50° FOV; 2361x1568
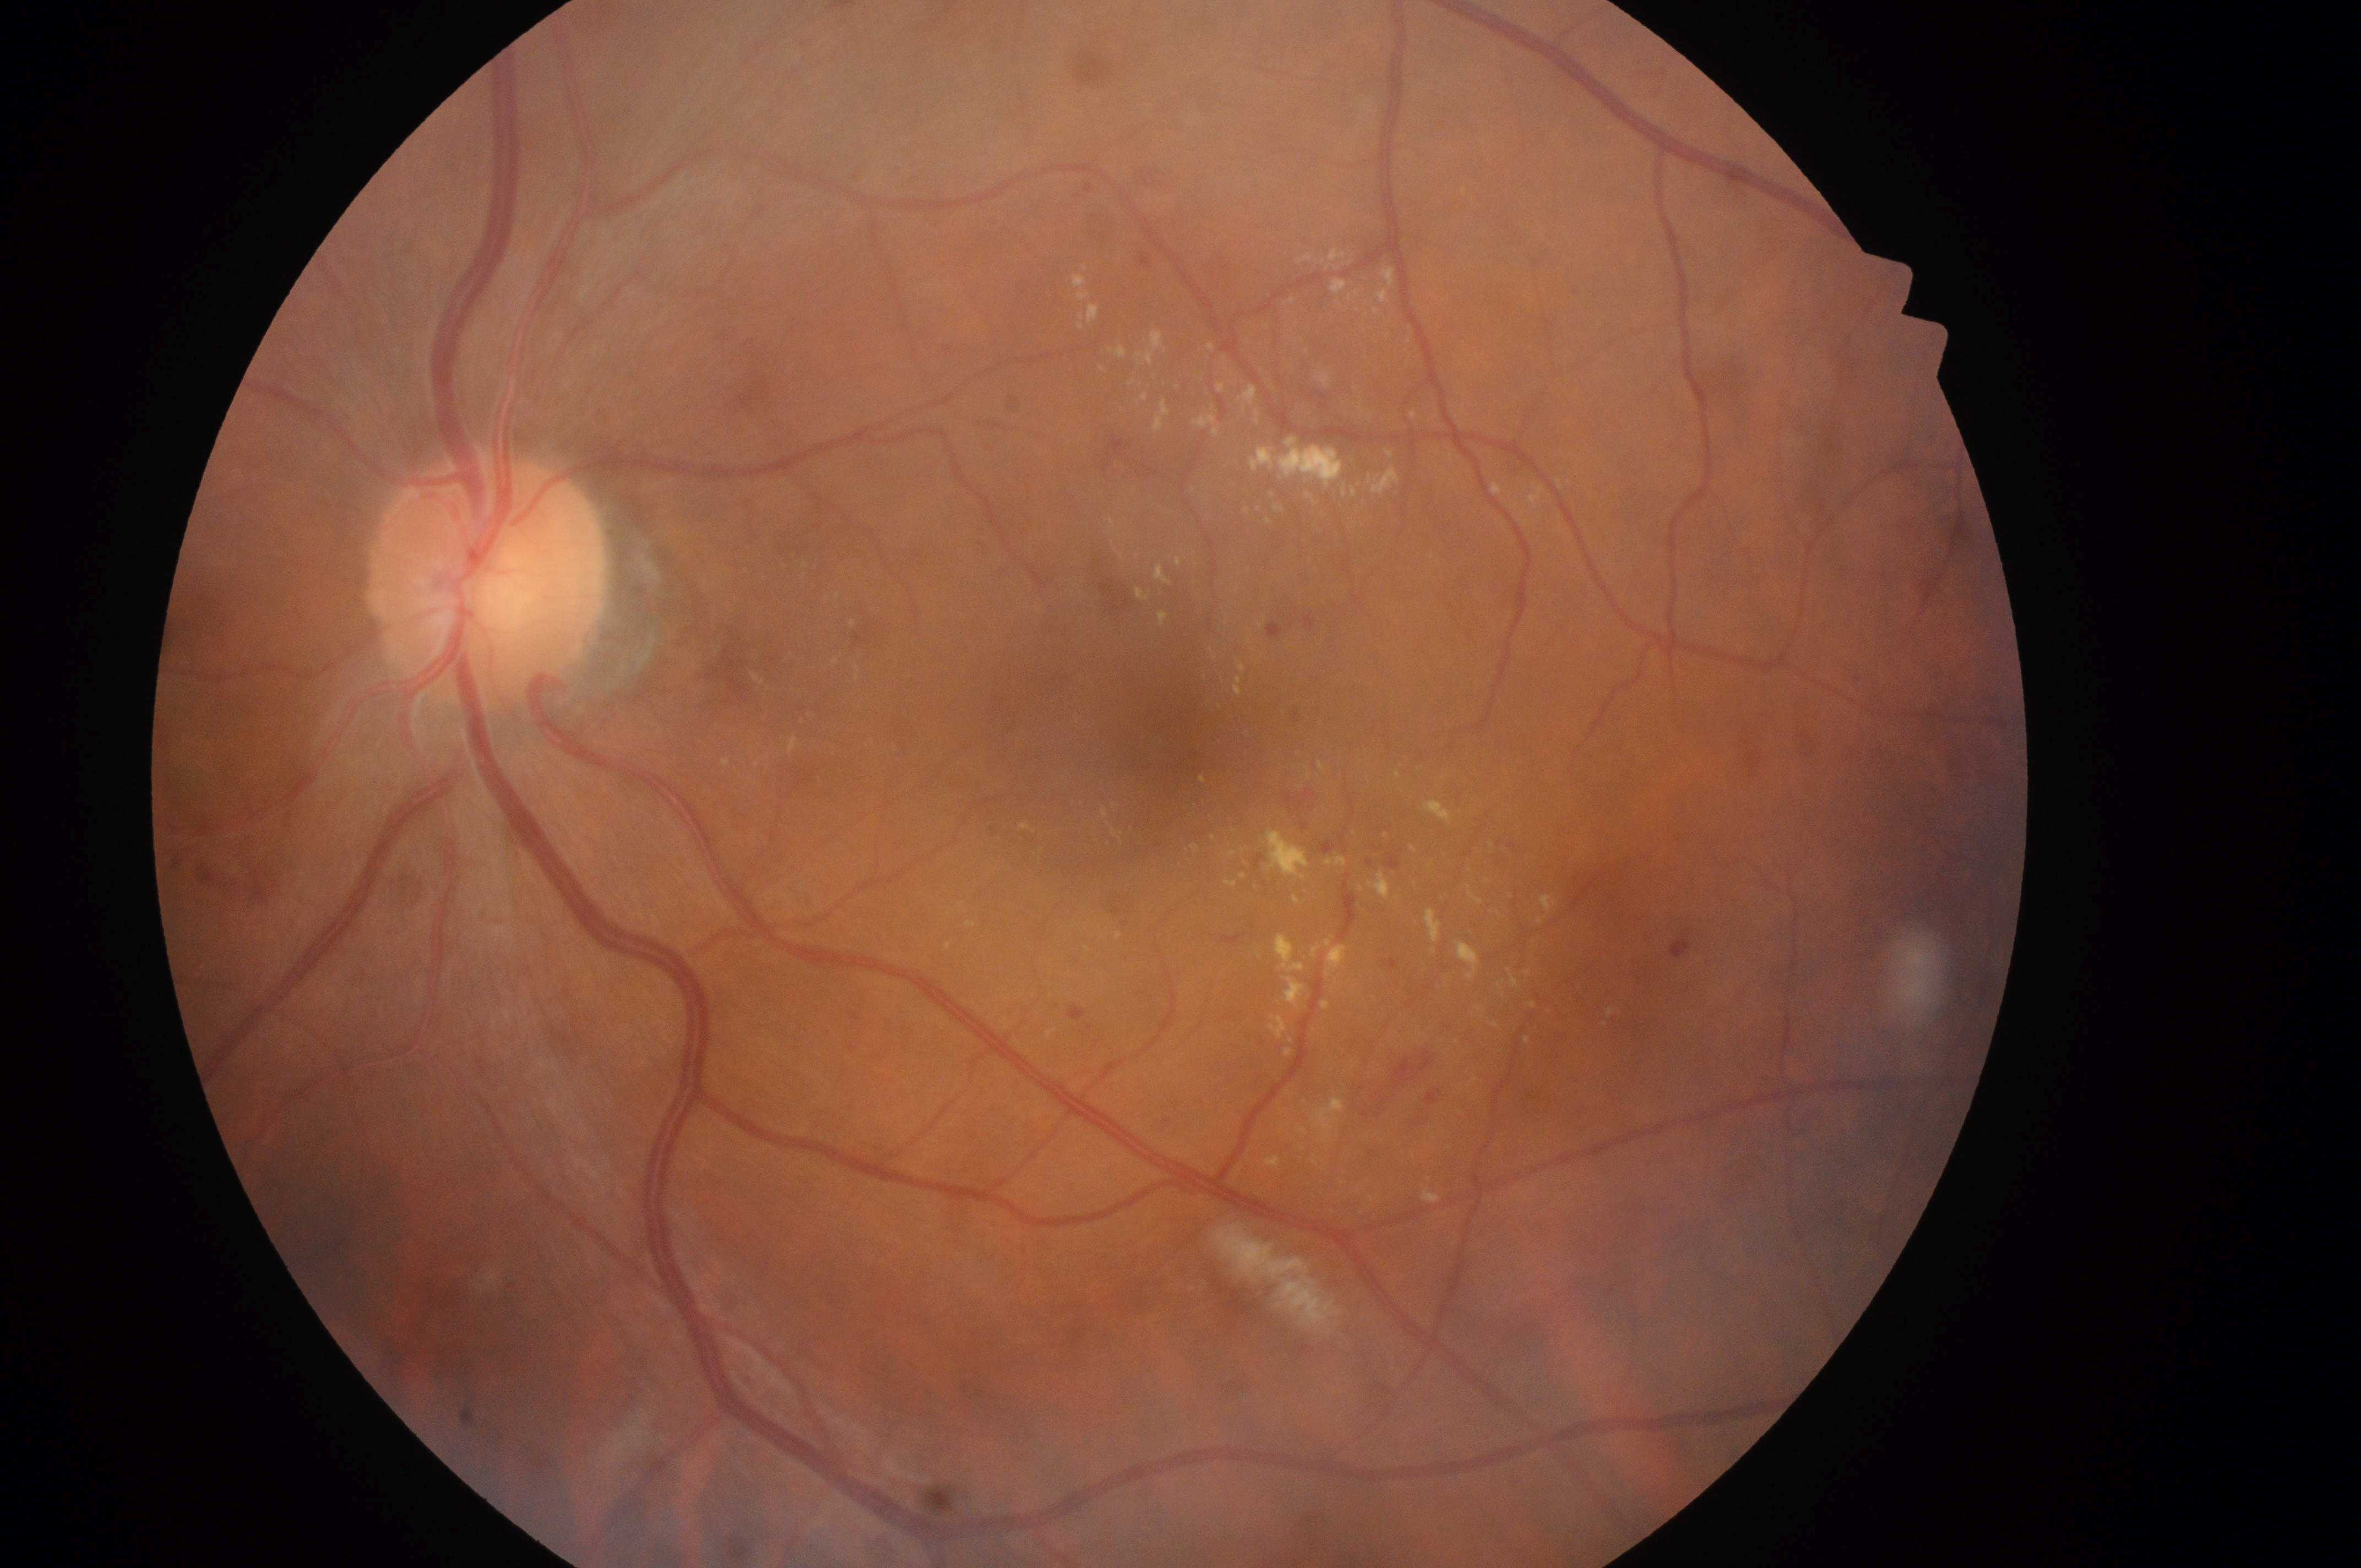

Macular edema risk is high risk (grade 2).
The optic disc center is at (476, 583).
Macula center located at (1169, 748).
Imaged eye: the left eye.
Retinopathy is moderate NPDR (grade 2).